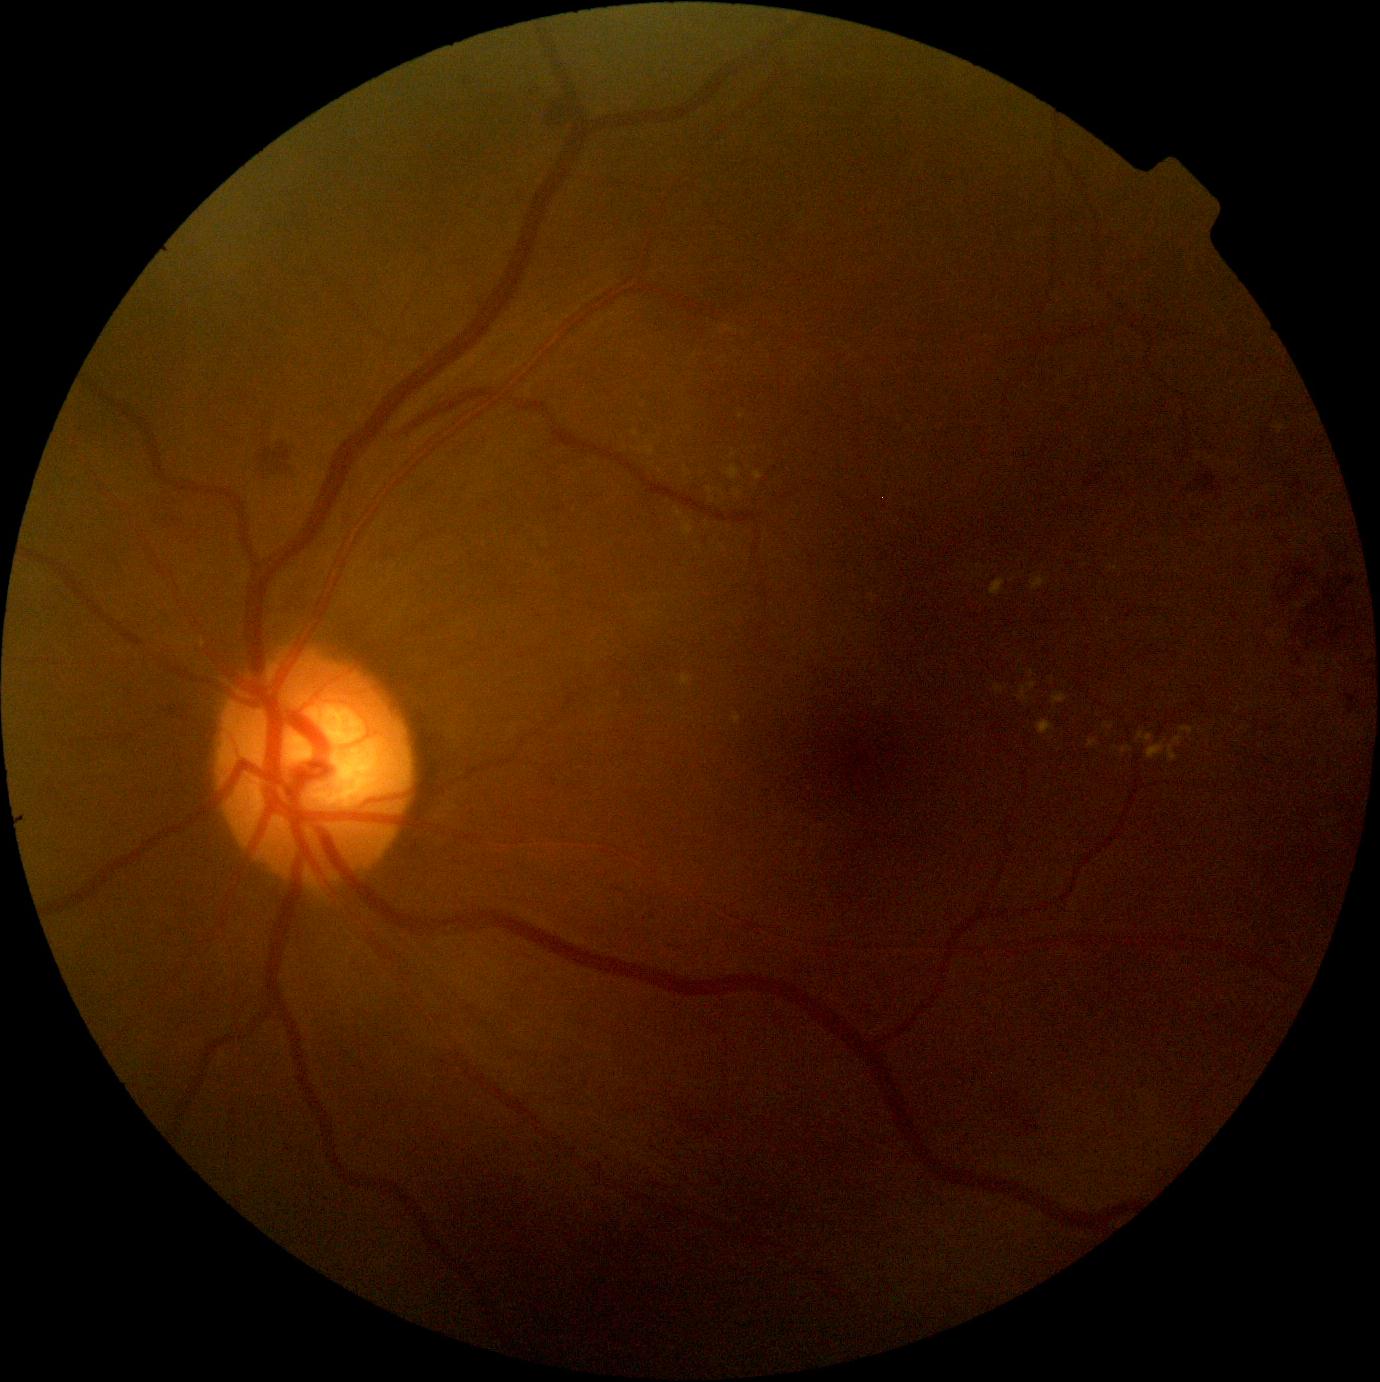

DR grade is moderate non-proliferative diabetic retinopathy (2)
Representative lesions:
EXs (partial): <bbox>1104, 722, 1115, 730</bbox> | <bbox>1109, 566, 1120, 572</bbox> | <bbox>1037, 721, 1055, 736</bbox> | <bbox>646, 446, 654, 457</bbox> | <bbox>734, 713, 742, 725</bbox> | <bbox>1053, 693, 1068, 706</bbox> | <bbox>1018, 683, 1038, 703</bbox> | <bbox>682, 520, 693, 538</bbox> | <bbox>1179, 726, 1195, 736</bbox> | <bbox>995, 685, 1008, 694</bbox>
Additional small EXs near 978, 566 | 1215, 777 | 1033, 674 | 636, 433 | 710, 491 | 1017, 635 | 975, 575
HEs (partial): <bbox>1294, 659, 1303, 666</bbox> | <bbox>165, 703, 194, 714</bbox> | <bbox>1349, 577, 1356, 585</bbox> | <bbox>1085, 475, 1101, 488</bbox> | <bbox>1291, 567, 1303, 578</bbox> | <bbox>1197, 473, 1222, 495</bbox>
Additional small HEs near 1308, 649 | 270, 471 | 1327, 596 | 1280, 579 | 1347, 580